Posterior pole photograph. Acquired with a NIDEK AFC-230. Graded on the modified Davis scale.
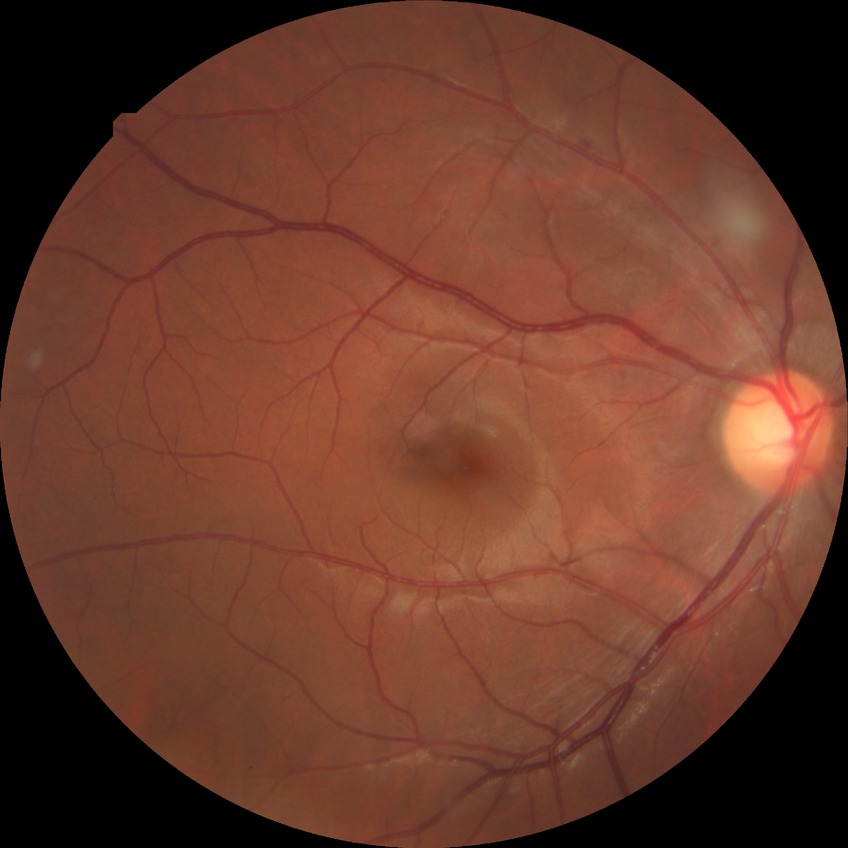 • diabetic retinopathy (DR): SDR (simple diabetic retinopathy)
• DR class: non-proliferative diabetic retinopathy